Undilated pupil · 2212x1661 · IOP 13 mmHg by non-contact tonometry · refraction: -1.25 -0.25 × 80° · retinal fundus photograph
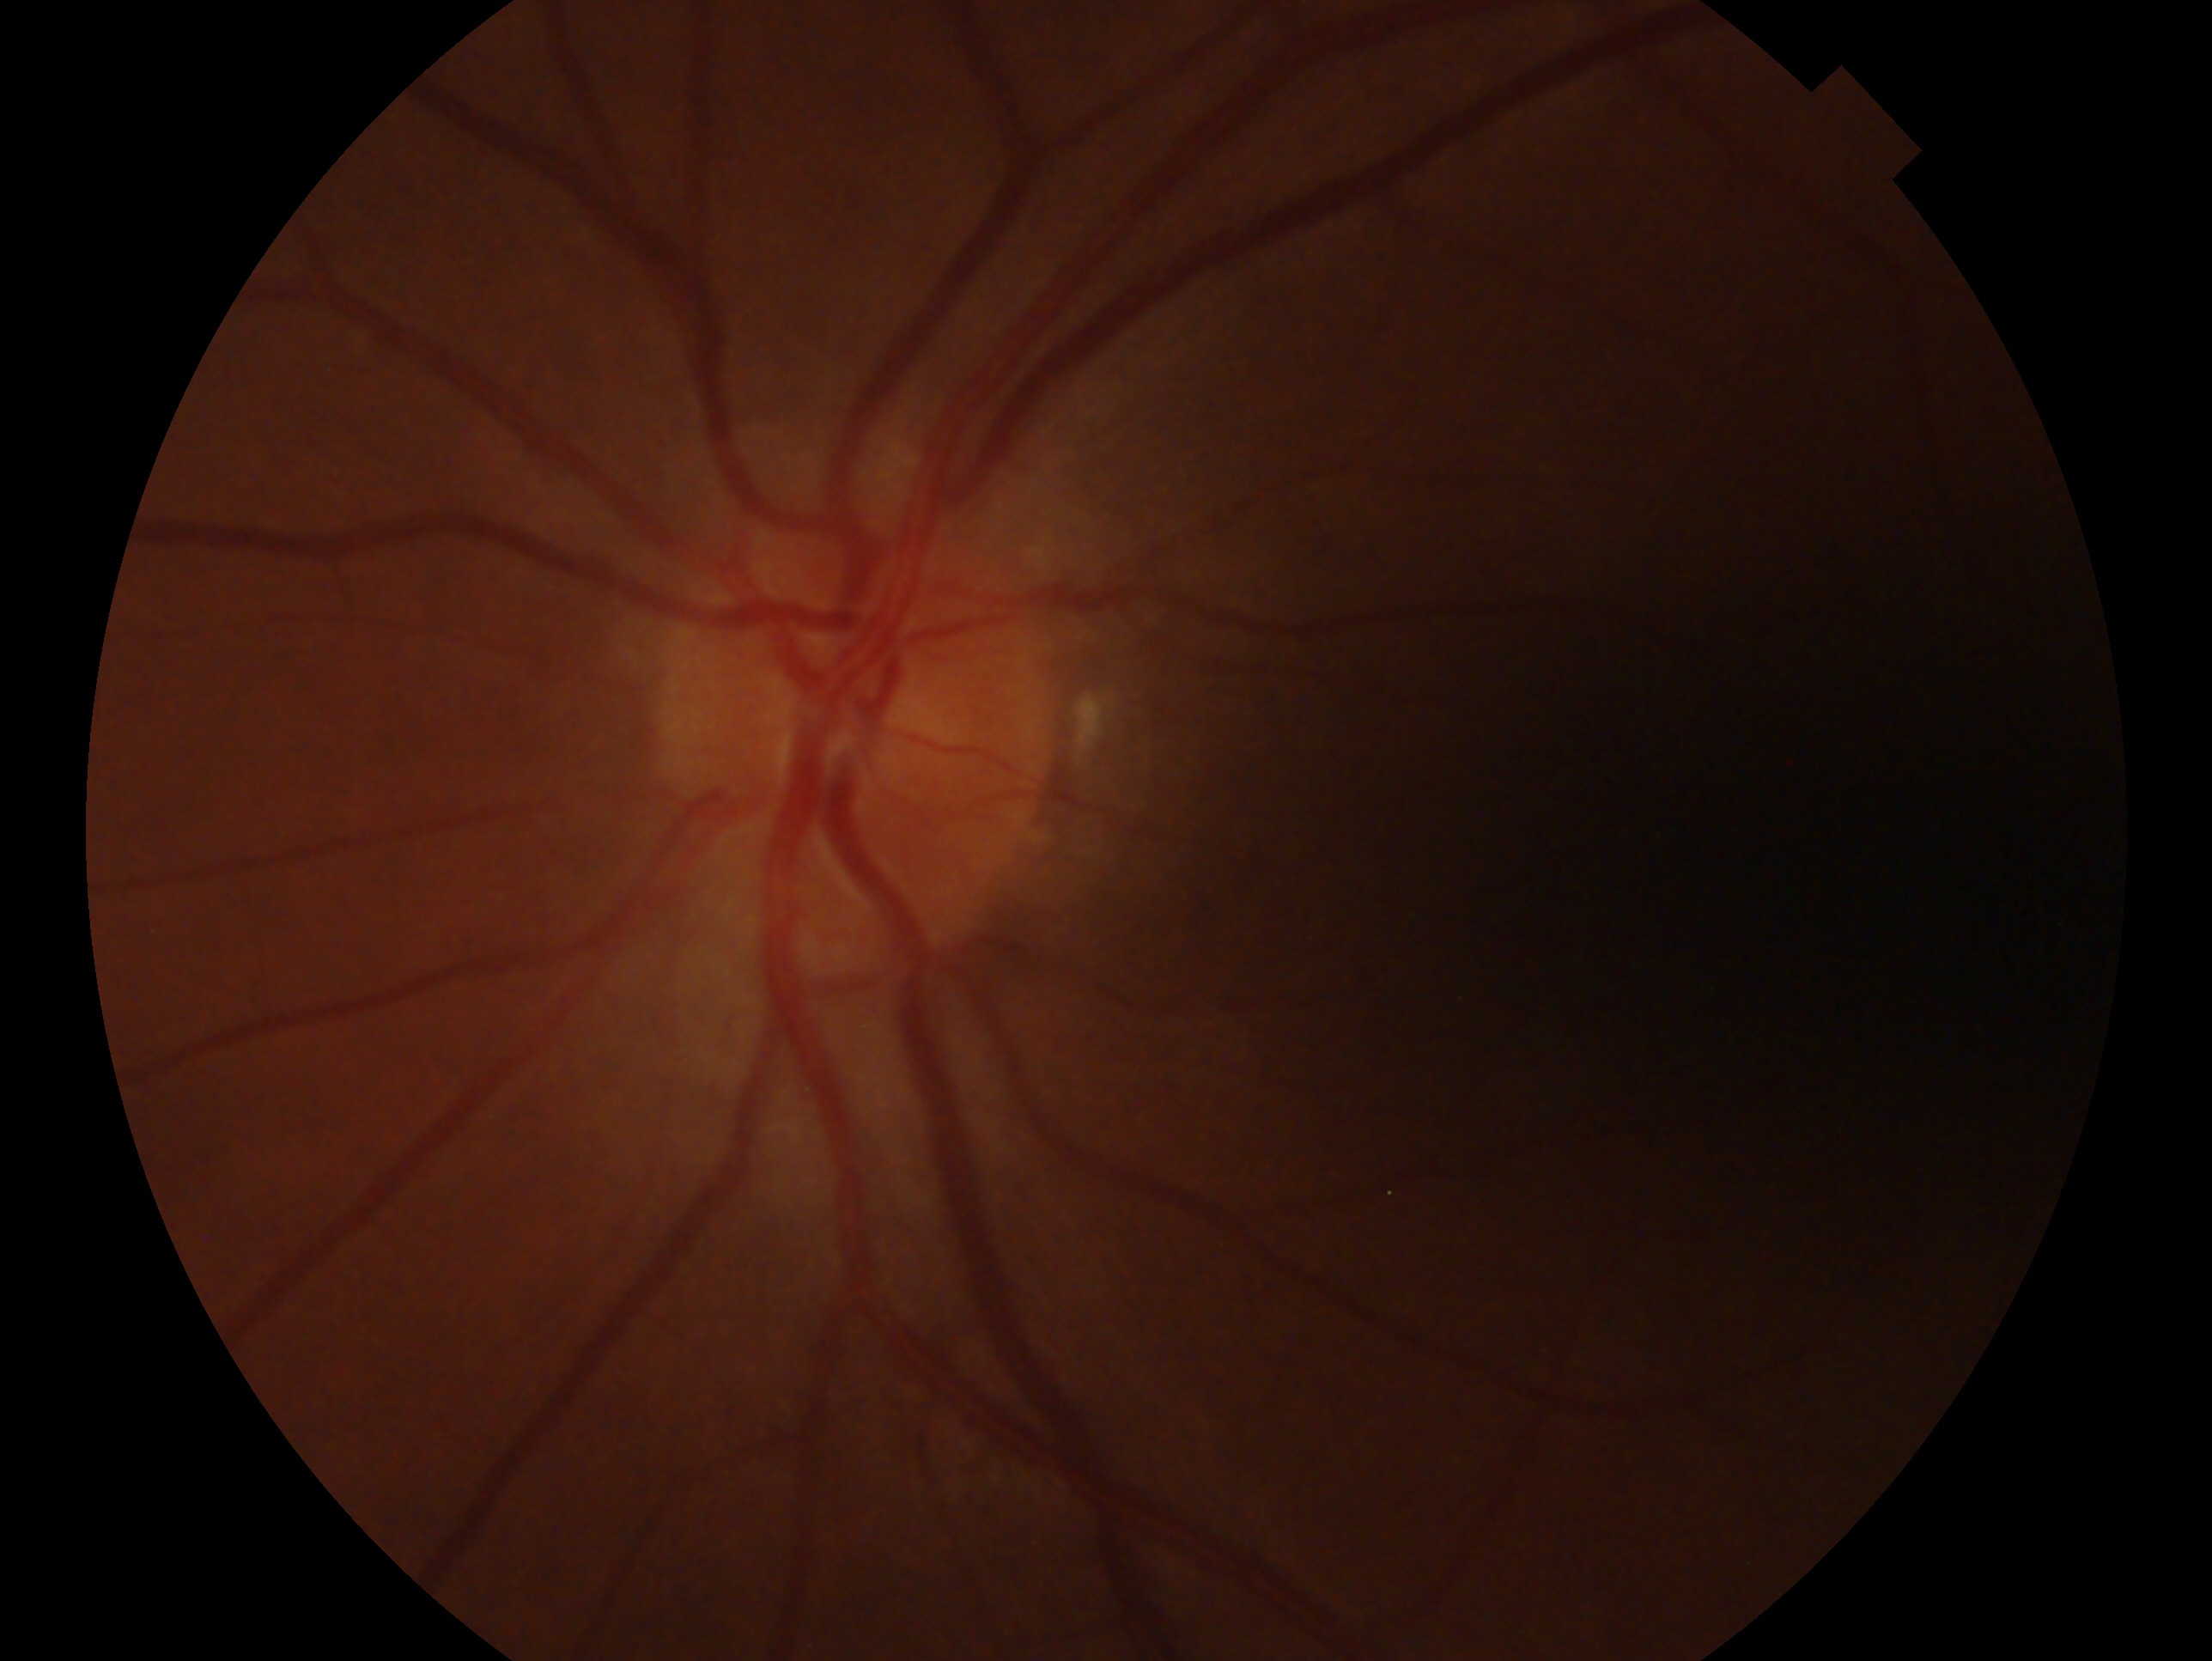 {"eye": "left", "glaucoma_dx": "no signs of glaucoma"}